1932 by 1932 pixels.
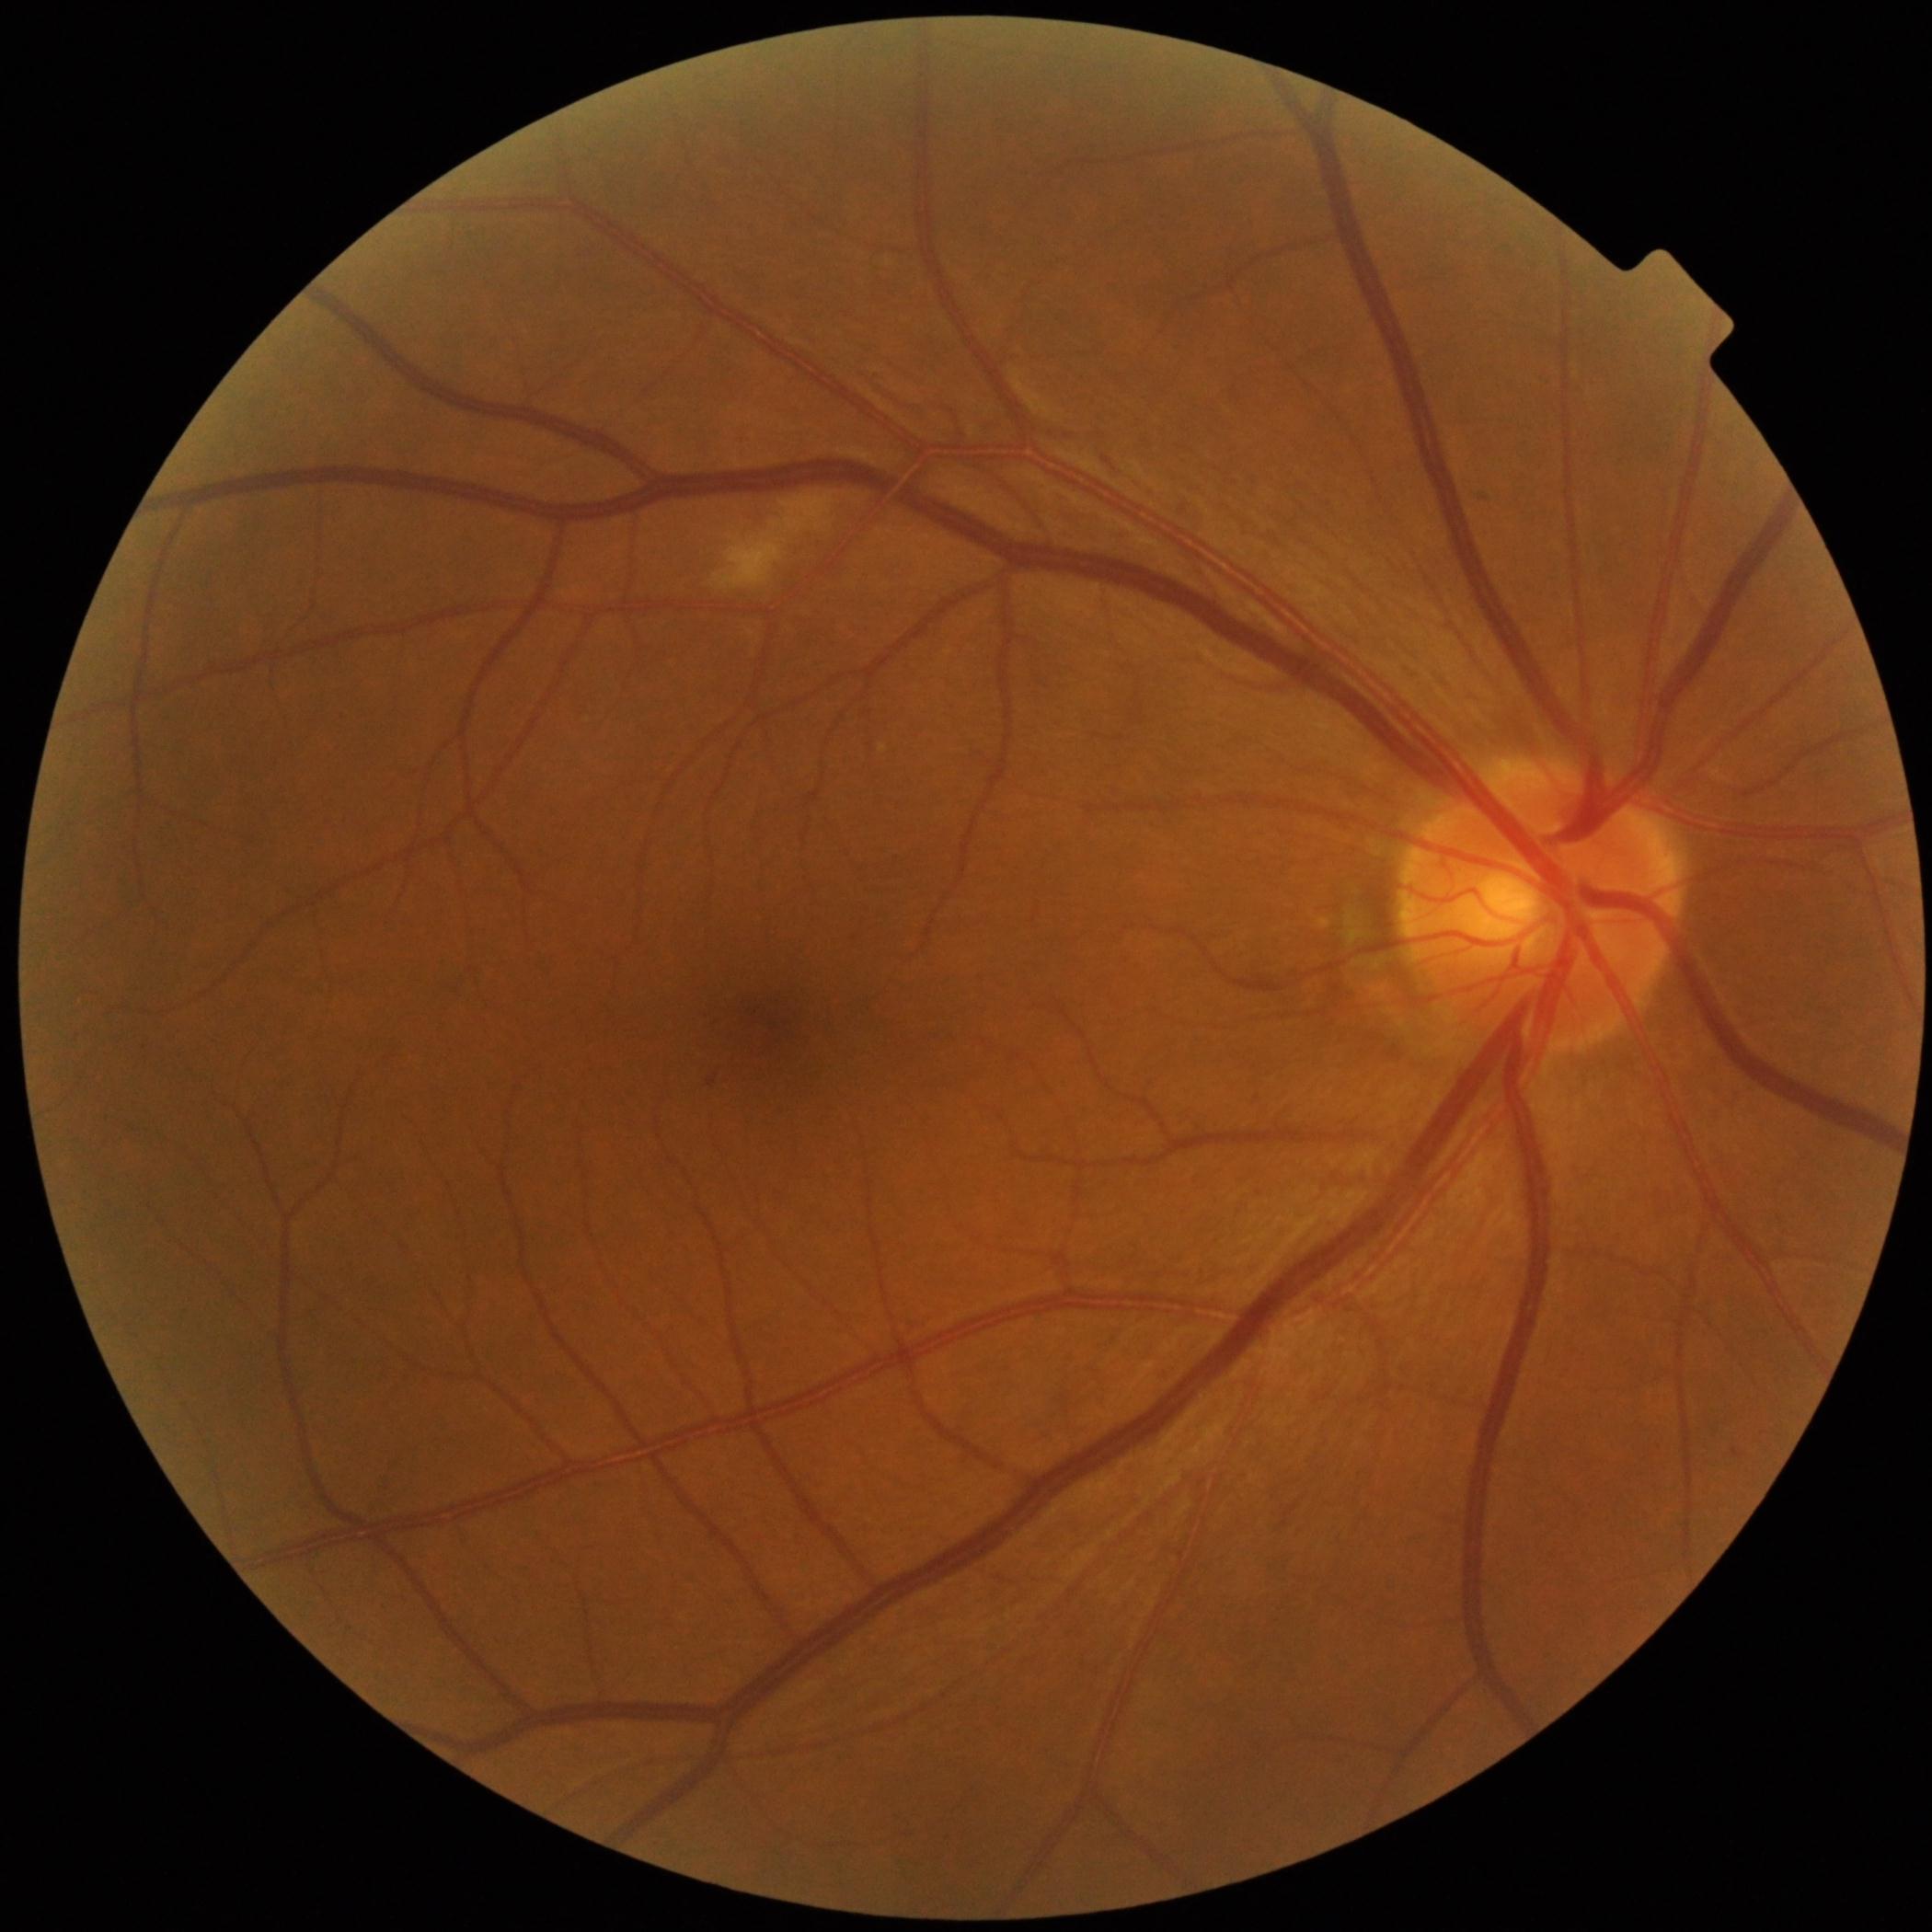 Diabetic retinopathy: 2.